Color fundus photograph. Diabetic retinopathy graded by the modified Davis classification. Nonmydriatic fundus photograph:
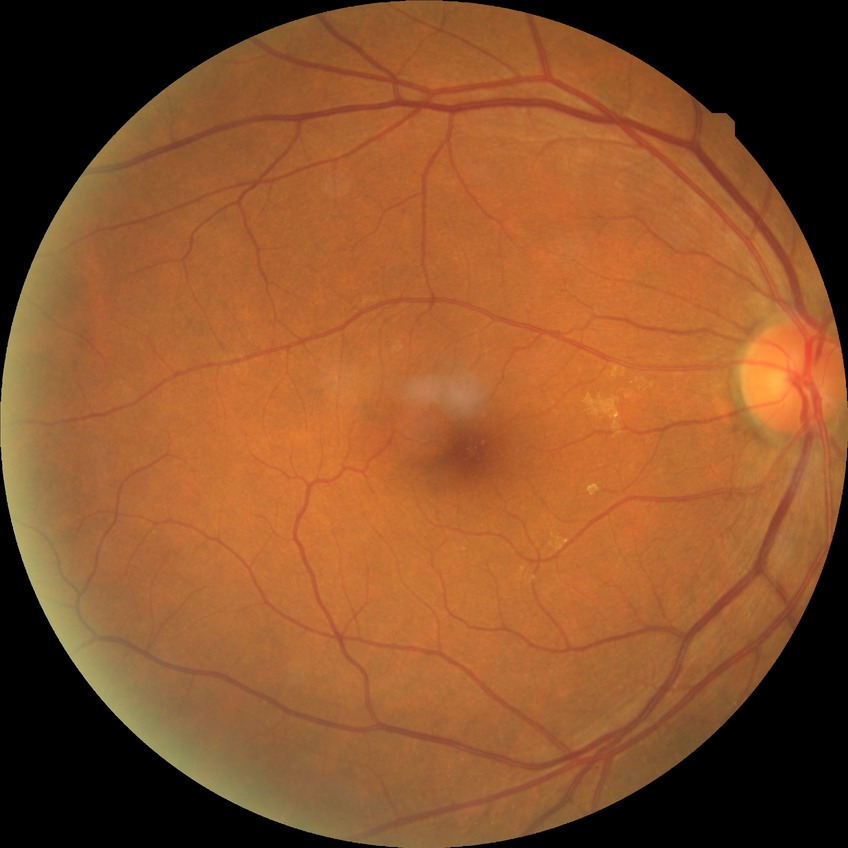

Davis DR grade = NDR.